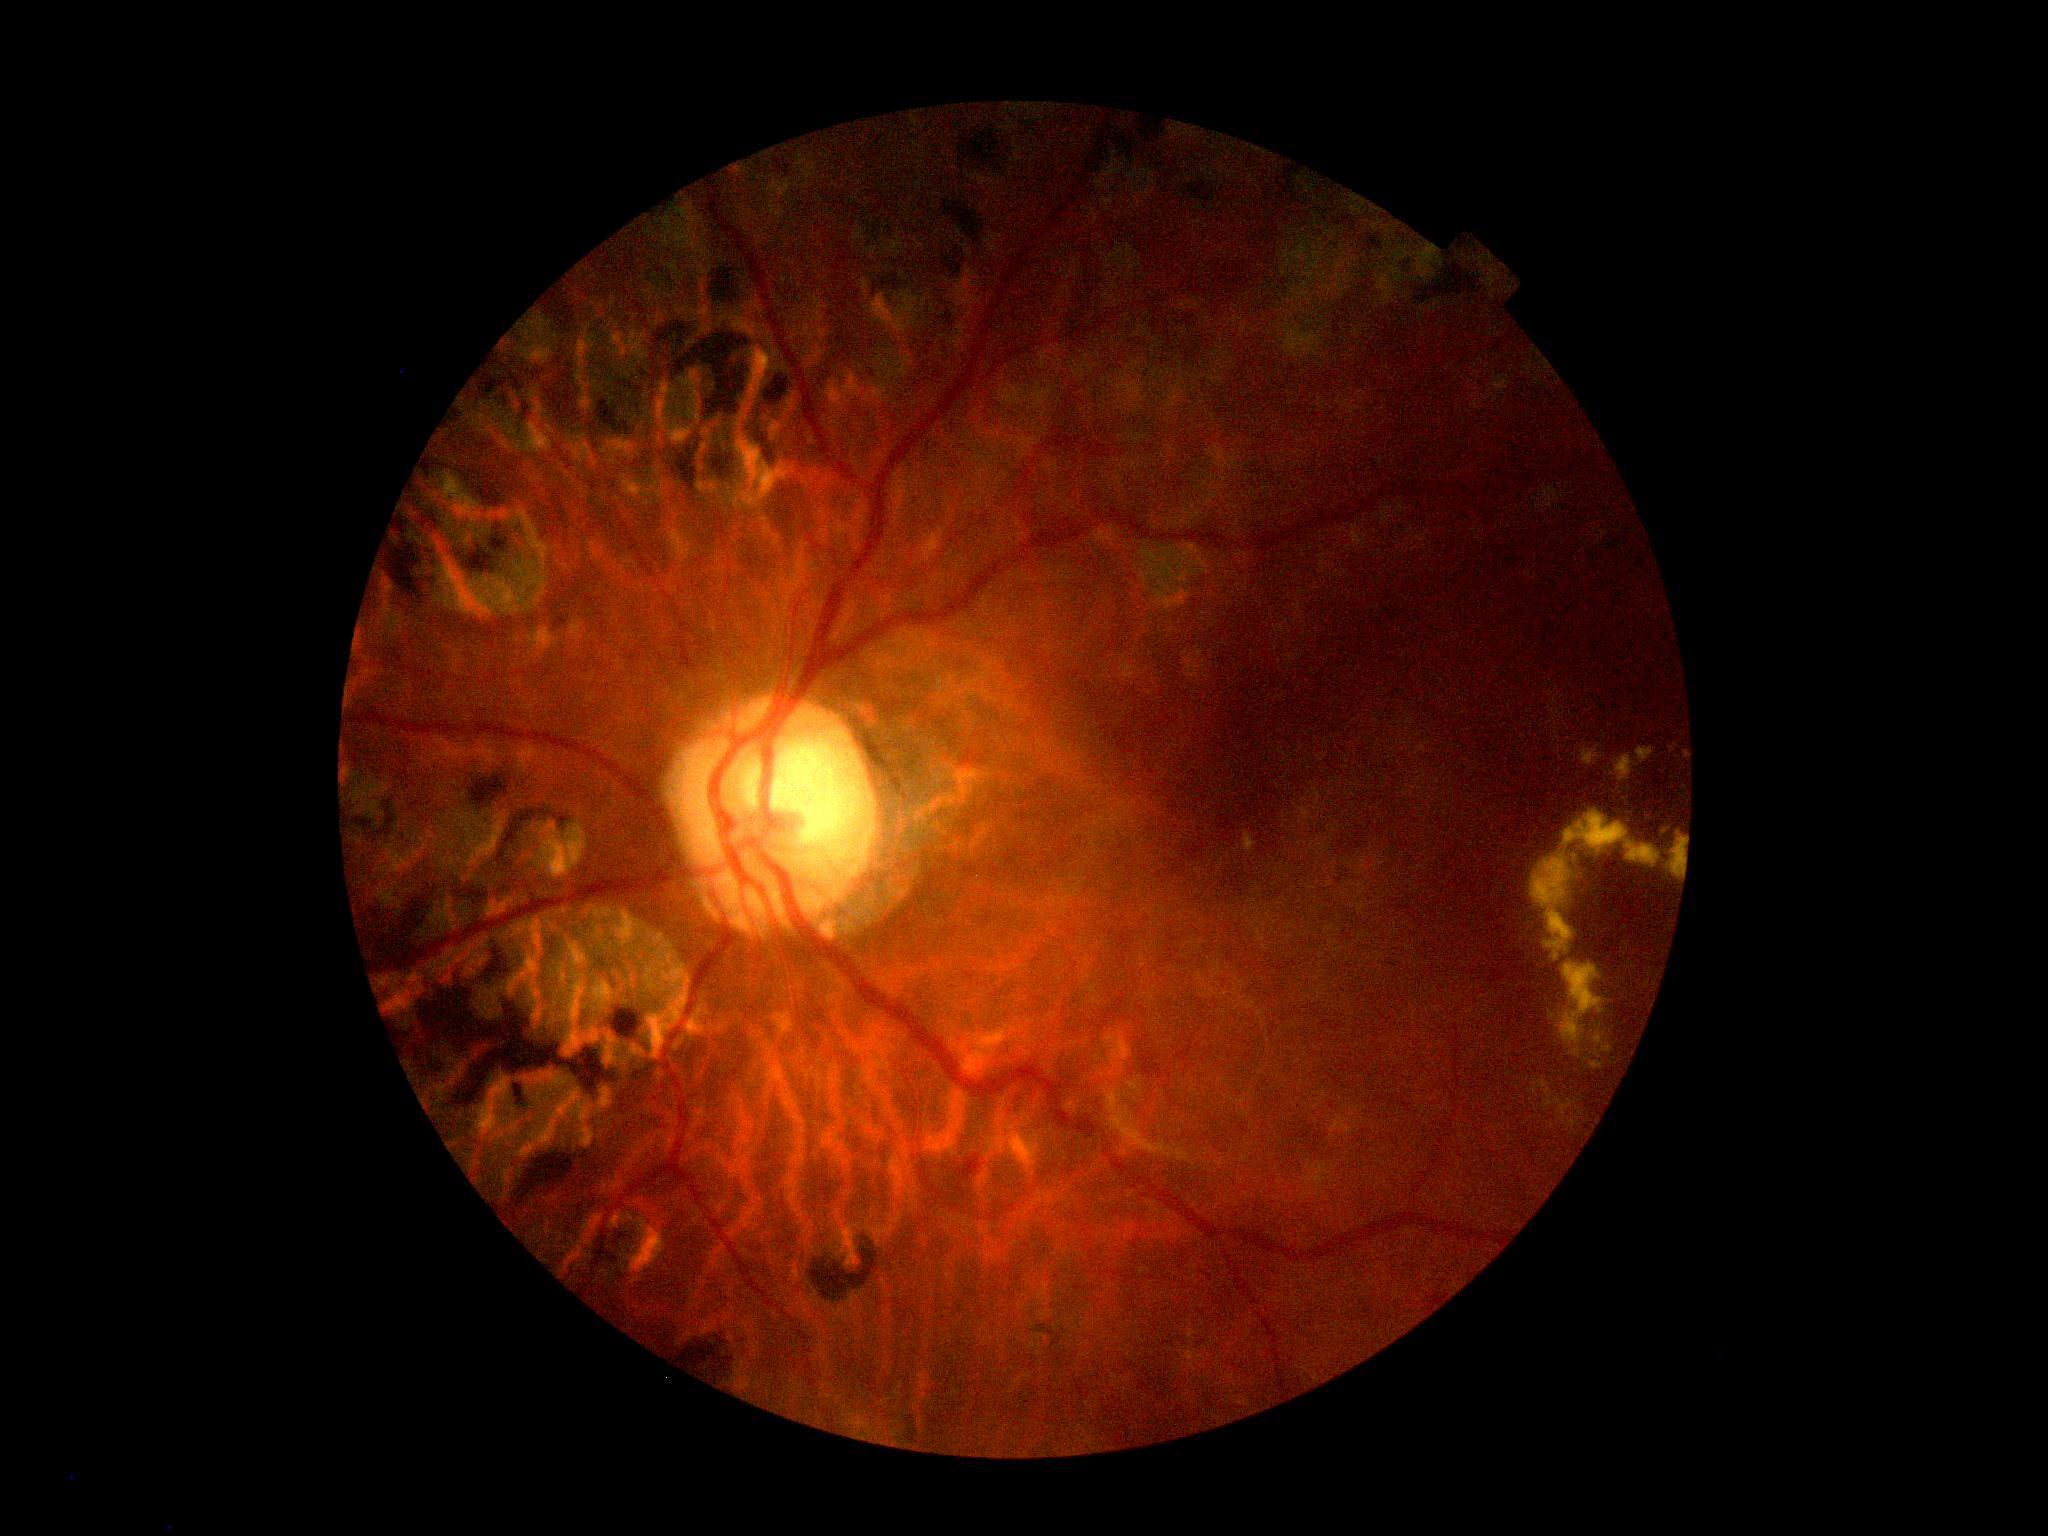 Retinopathy is grade 2 (moderate NPDR). Disease class: non-proliferative diabetic retinopathy.